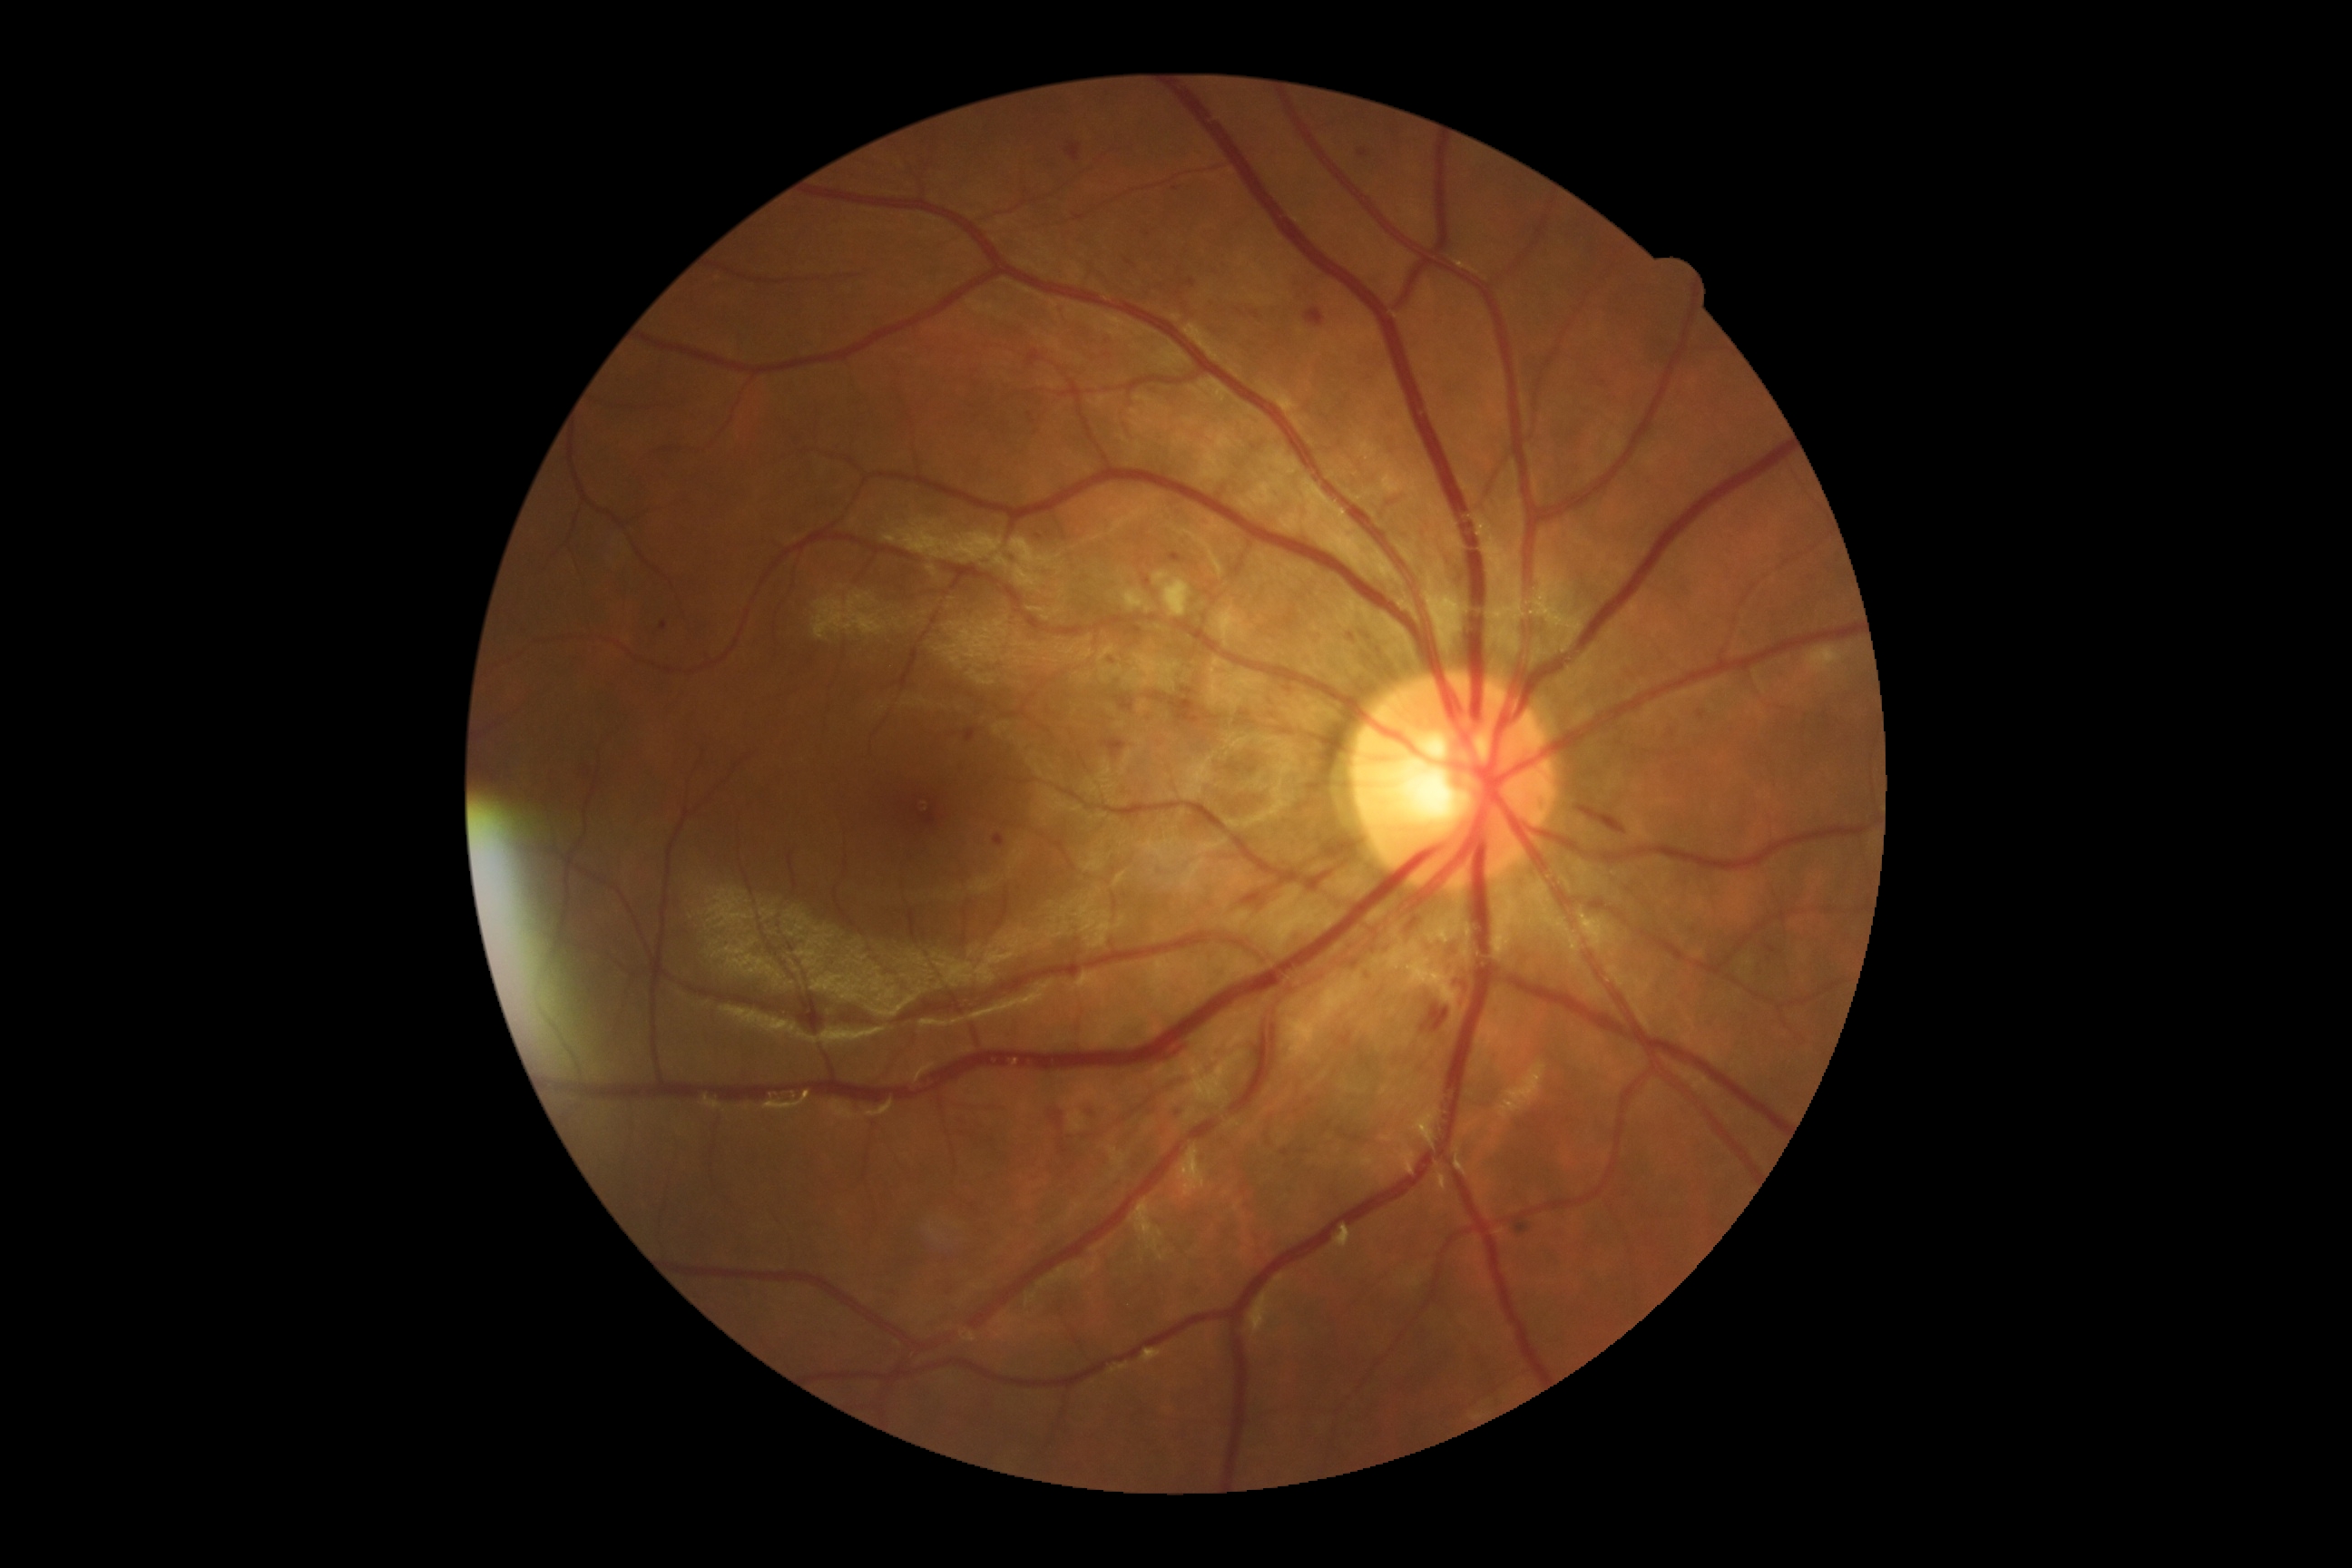 Annotations:
- retinopathy: grade 2
- DR class: non-proliferative diabetic retinopathy